Phoenix ICON wide-field infant fundus image. Phoenix ICON, 100° FOV. Image size 1240x1240.
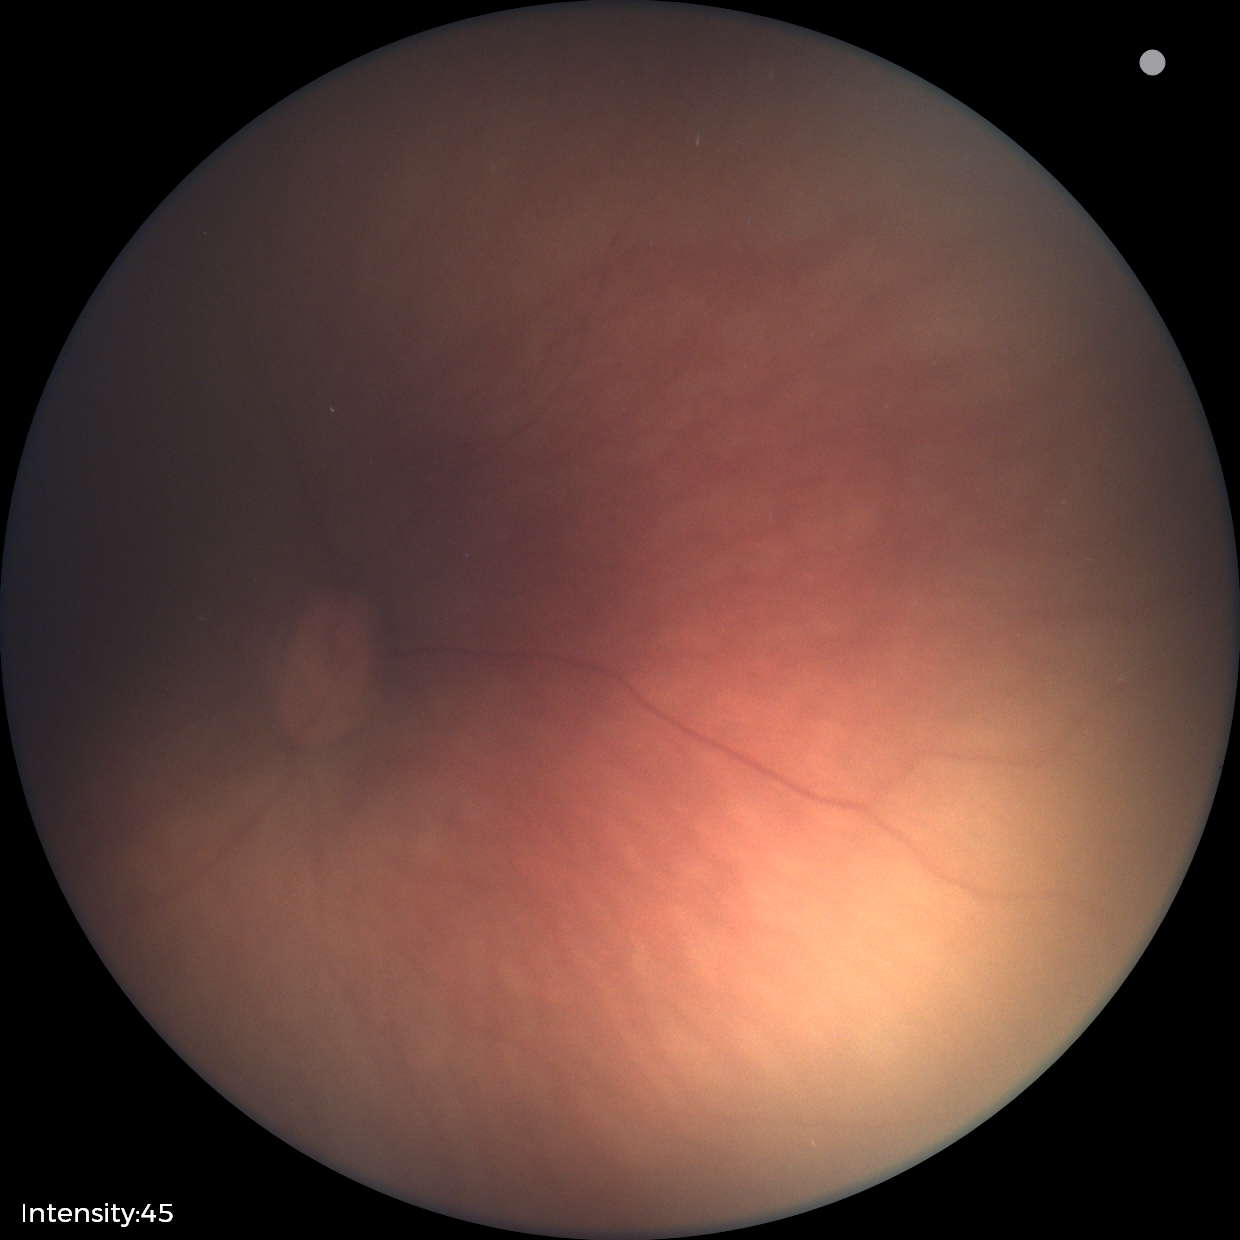 Examination with physiological retinal findings.